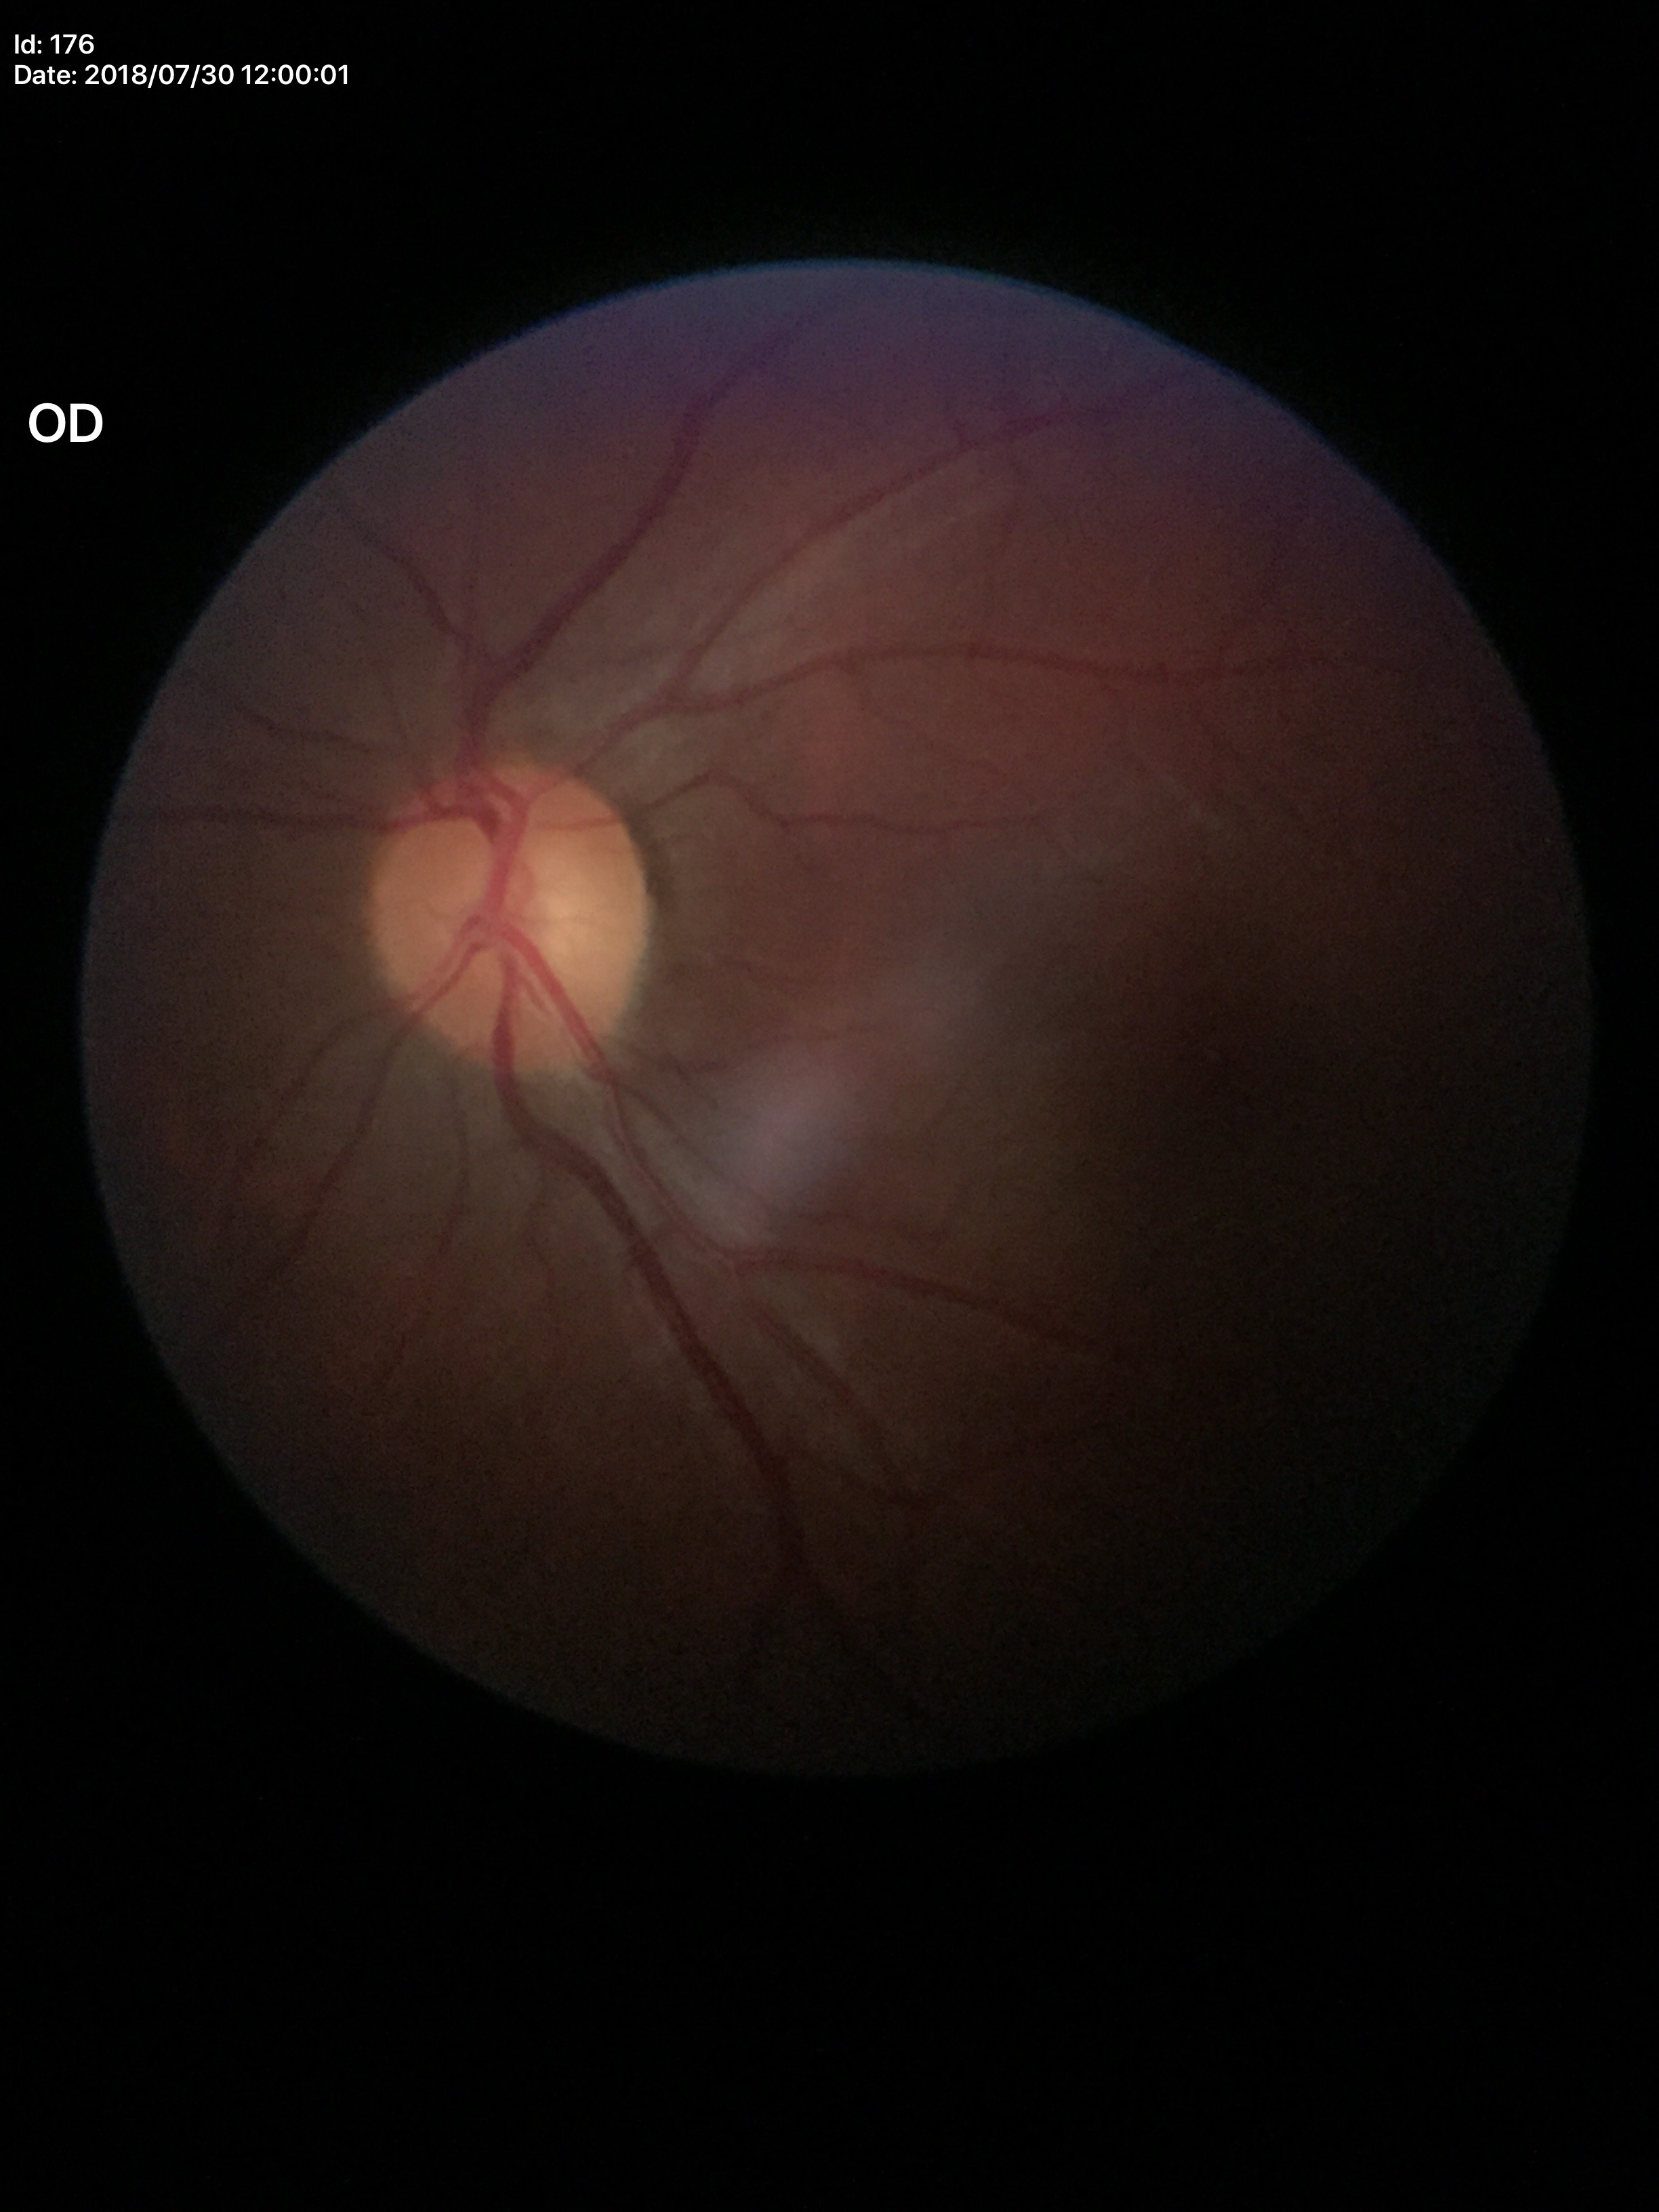

Glaucoma decision: no suspicious findings. HCDR is 0.48. ACDR: 0.22. VCDR of 0.47.